Camera: Nidek AFC-330. Captured without pupil dilation. Disc-centered field.
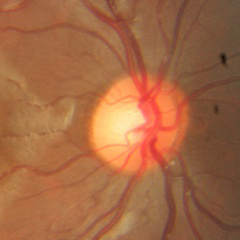

Diagnosis = no glaucoma.